Image size 640x480 · infant wide-field retinal image: 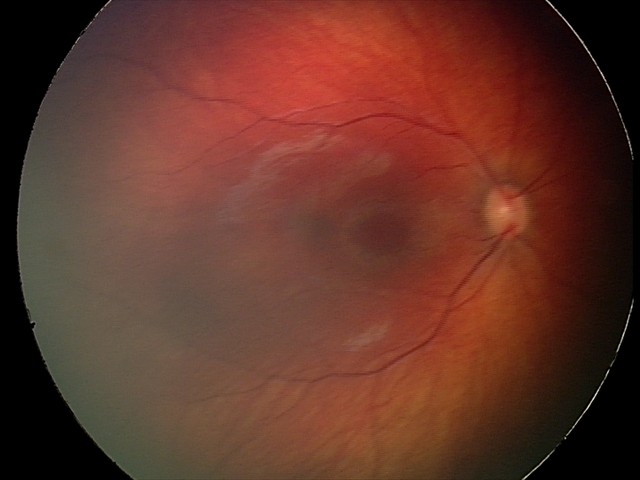

From an examination with diagnosis of retinal hemorrhages.